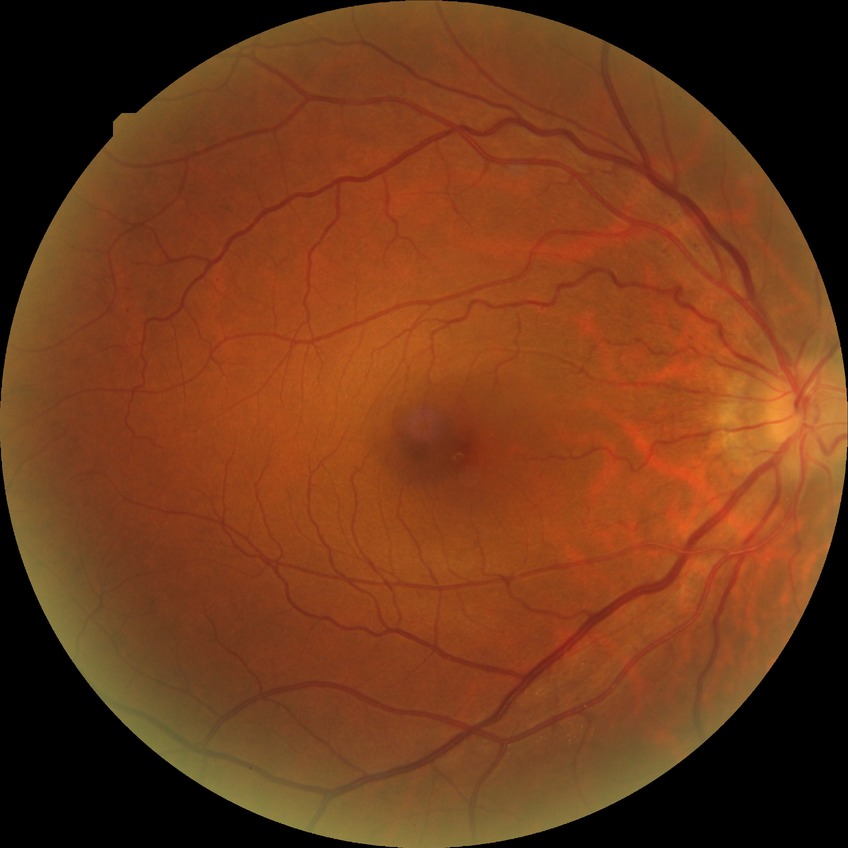
Annotations:
• retinopathy stage — simple diabetic retinopathy